Pediatric wide-field fundus photograph:
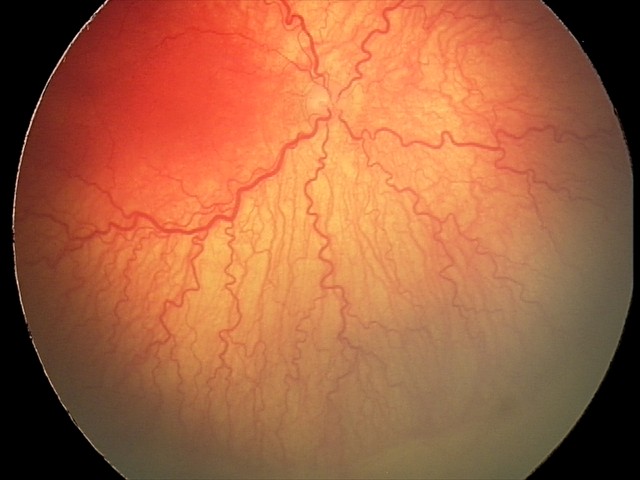
Plus disease was diagnosed.
Screening examination consistent with aggressive retinopathy of prematurity.